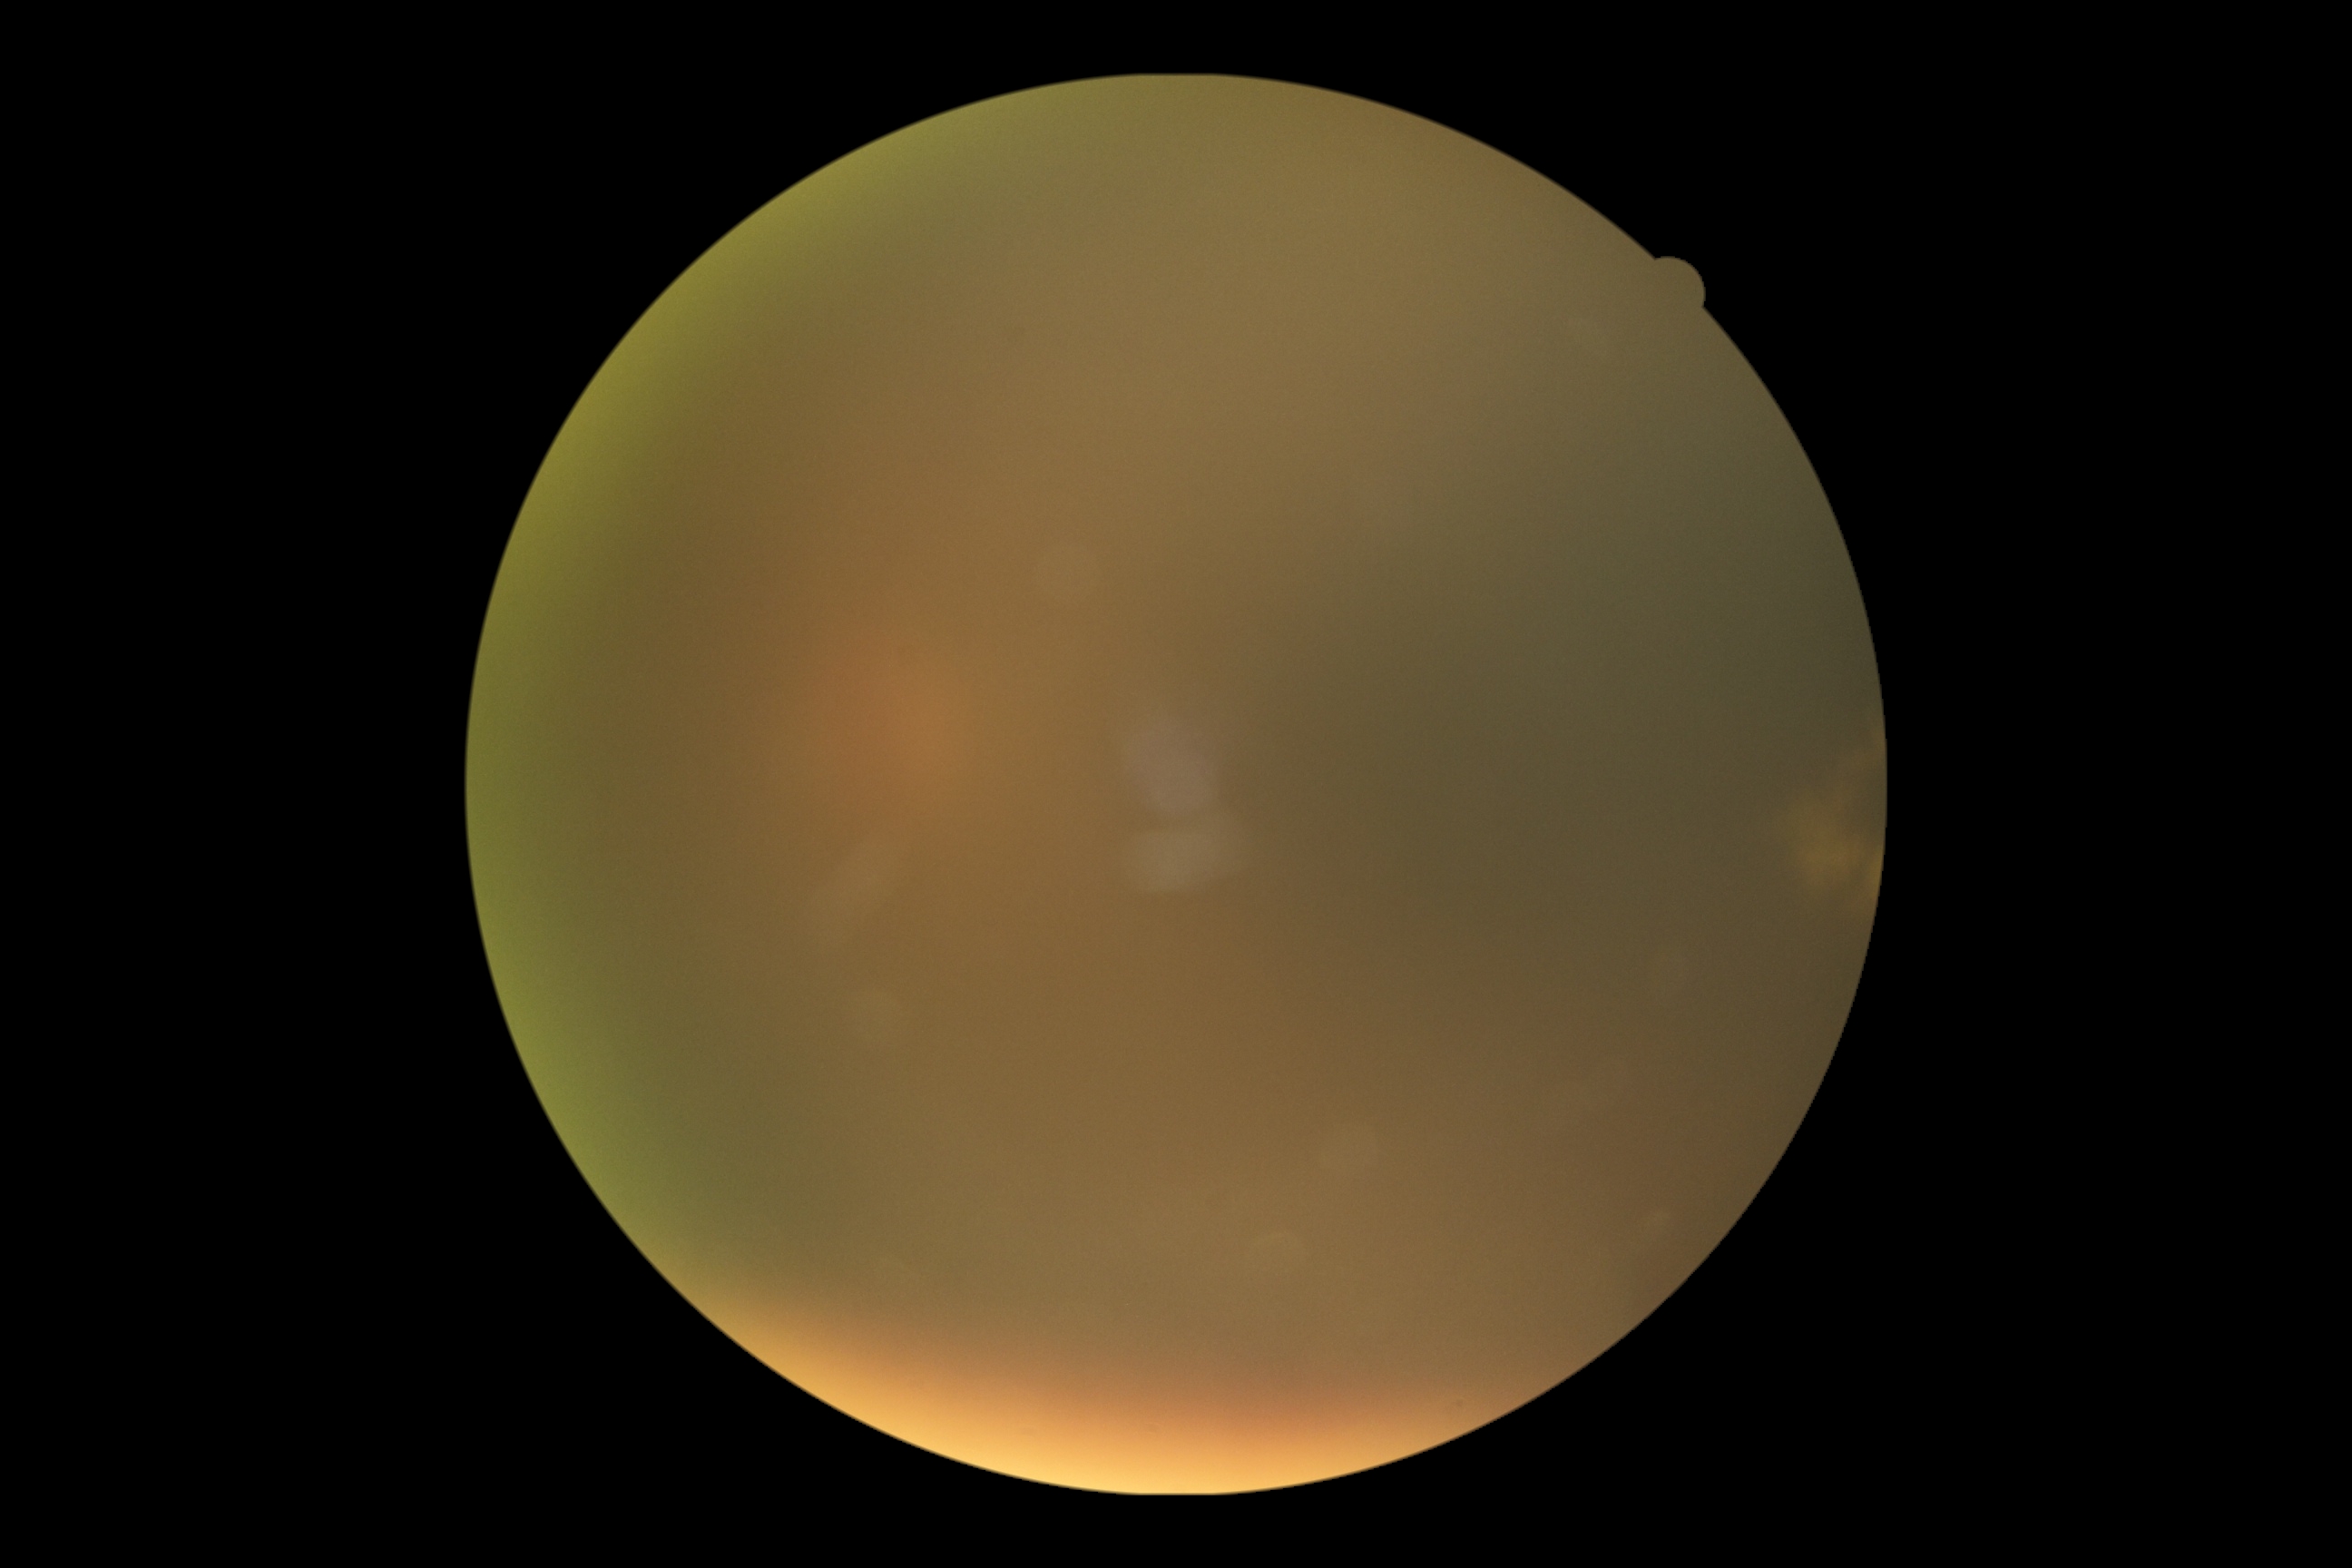
Diabetic retinopathy severity is ungradable.